45-degree field of view, posterior pole color fundus photograph, camera: NIDEK AFC-230, no pharmacologic dilation.
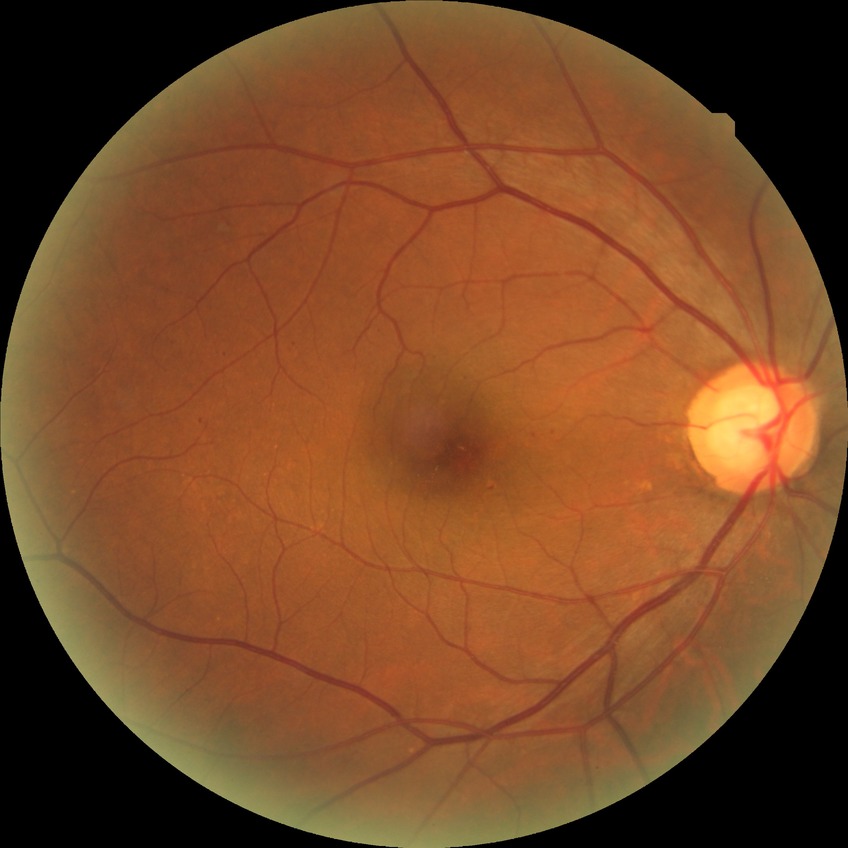
DR stage: SDR.